Nonmydriatic fundus photograph, 45-degree field of view: 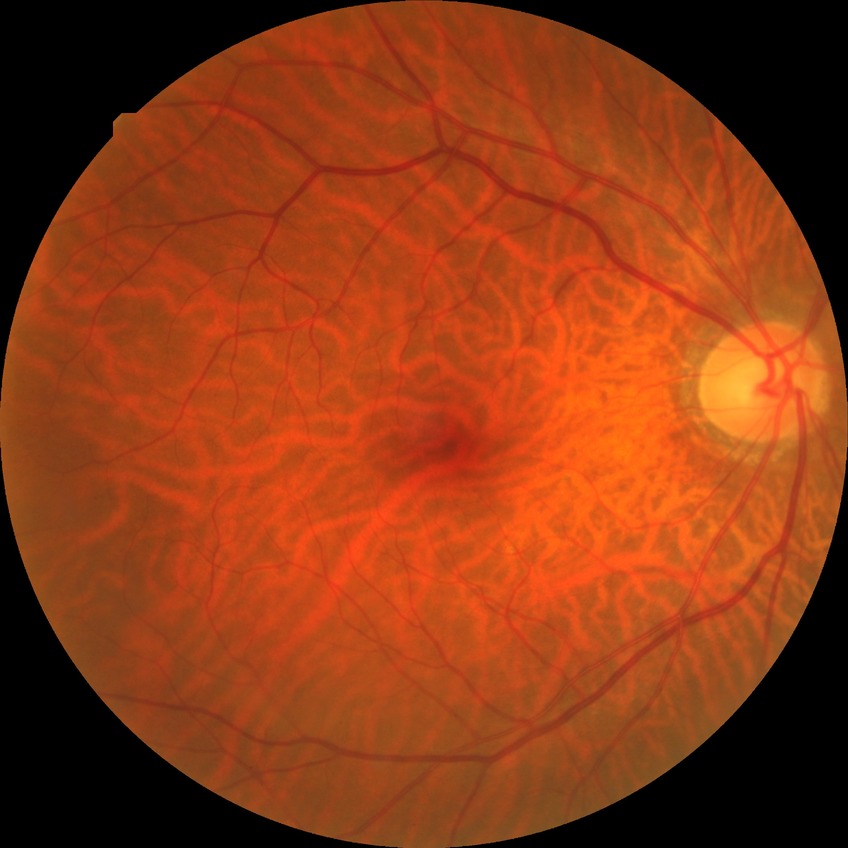
Davis DR grade: NDR.